Image size 1240x1240 · infant wide-field fundus photograph: 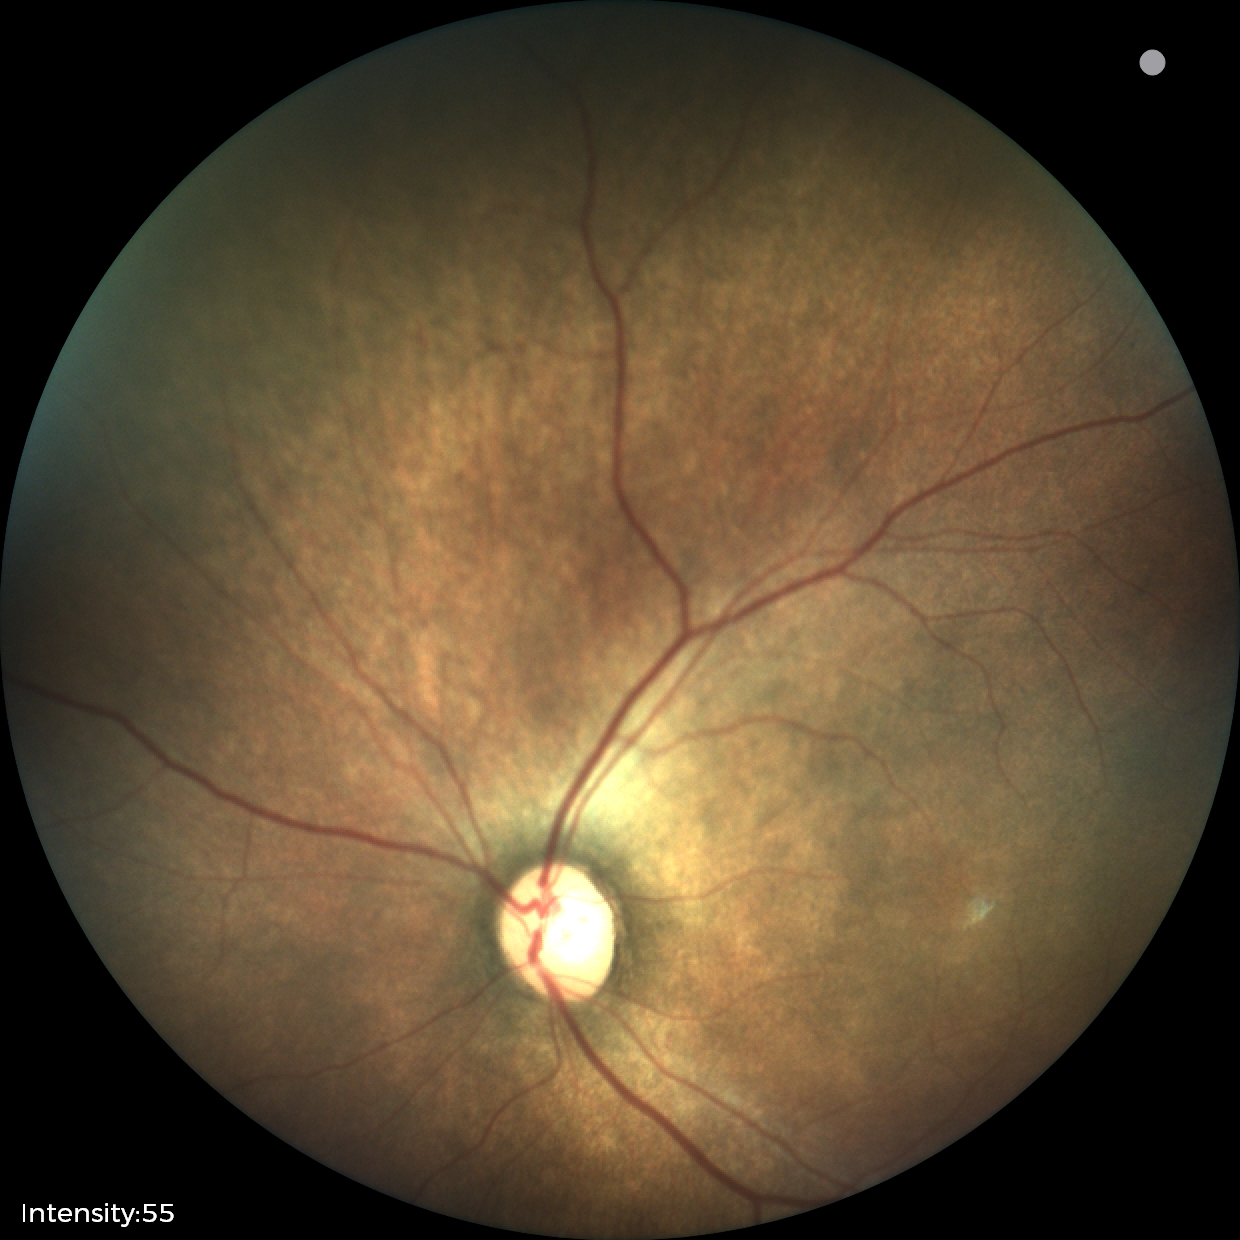
Series diagnosed as status post retinopathy of prematurity (ROP).
Without plus disease.